Color fundus photograph — 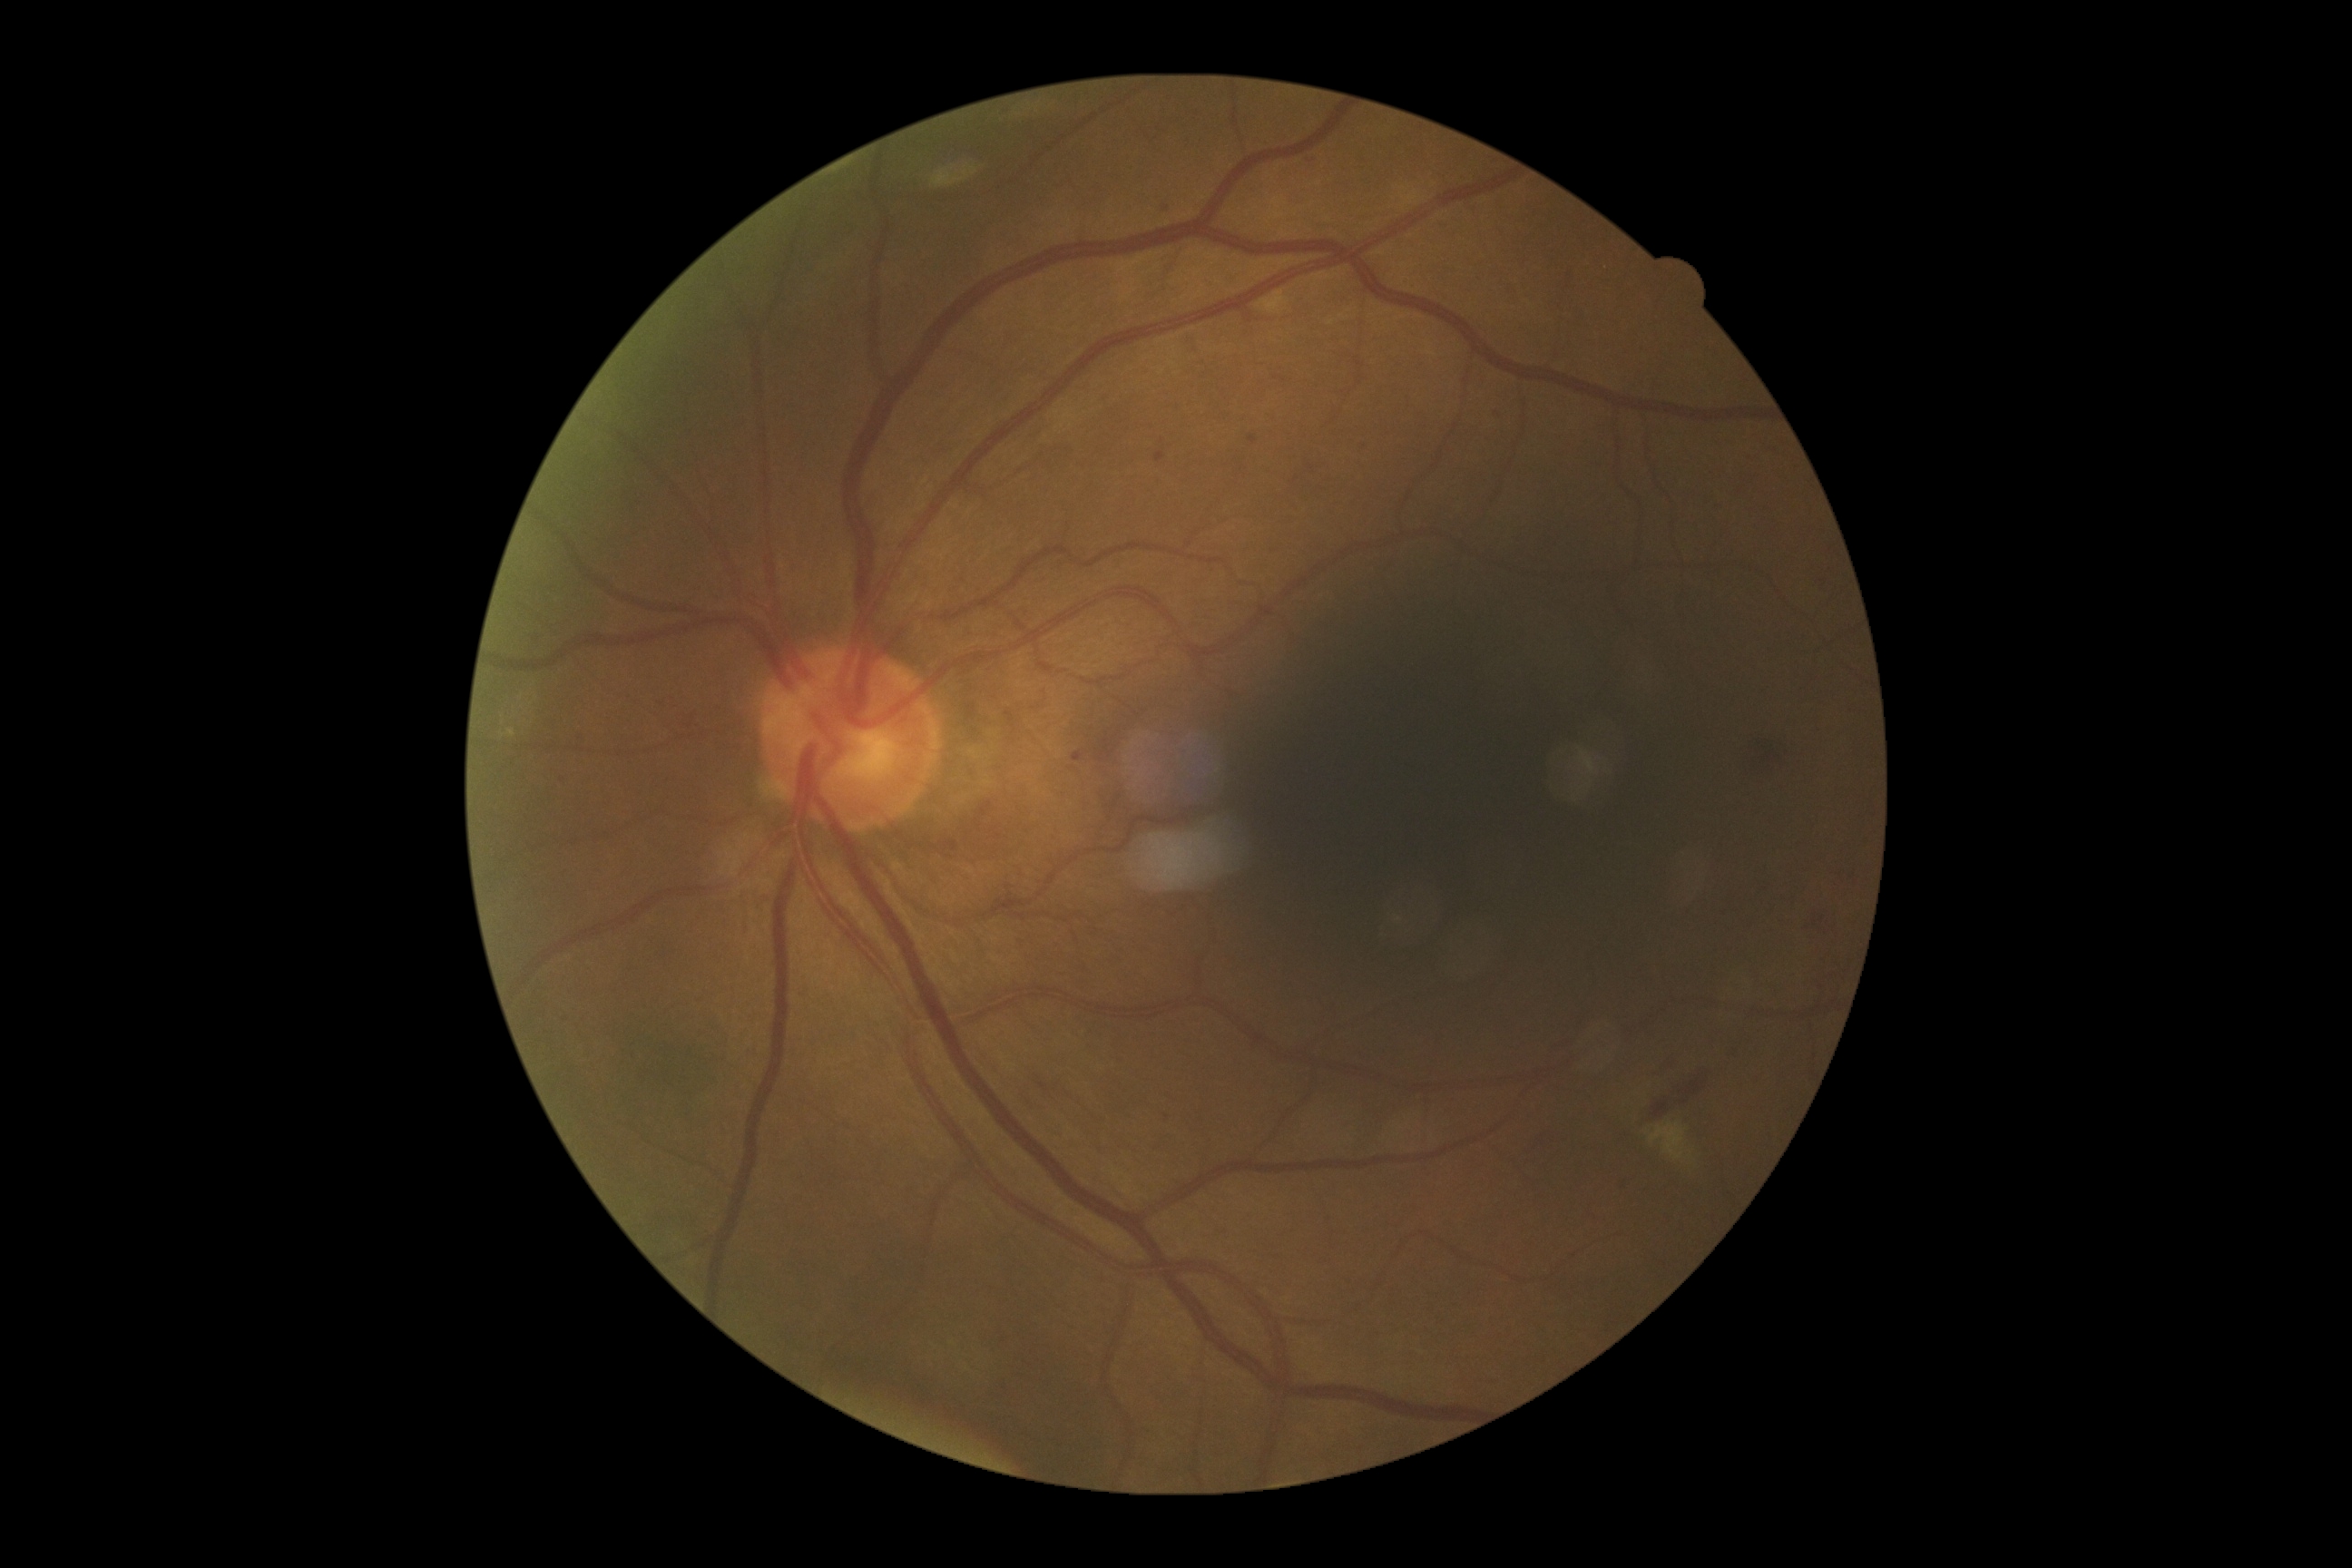 diabetic retinopathy severity: moderate non-proliferative diabetic retinopathy (grade 2).